DR severity per modified Davis staging
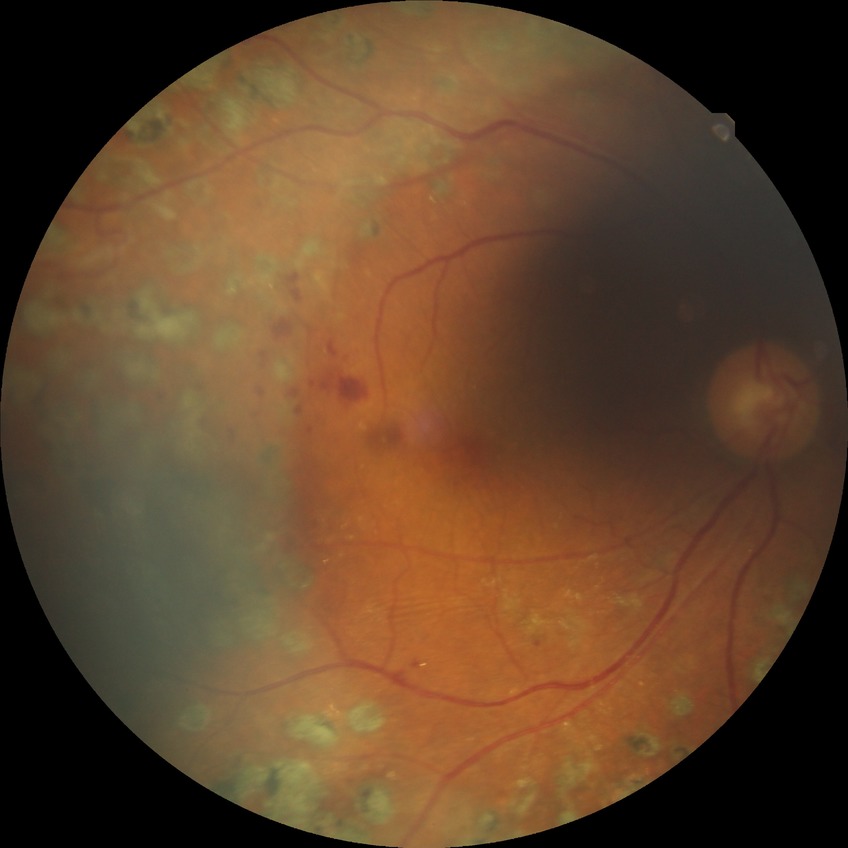 diabetic retinopathy grade = proliferative diabetic retinopathy.